Wide-field contact fundus photograph of an infant · camera: Clarity RetCam 3 (130° FOV) — 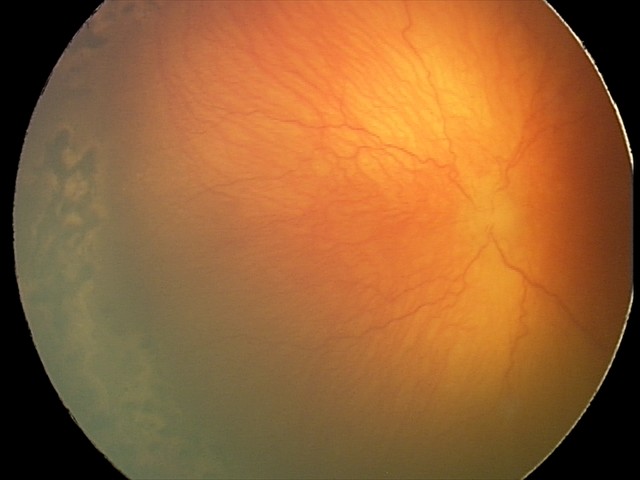
Impression: aggressive retinopathy of prematurity (A-ROP) | plus disease.